Pediatric retinal photograph (wide-field). 640 x 480 pixels. Camera: Clarity RetCam 3 (130° FOV).
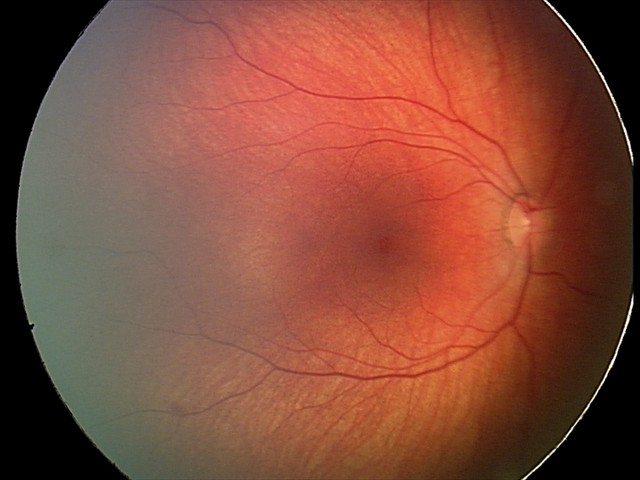

Q: What was the screening finding?
A: retinal hemorrhages